Modified Davis grading
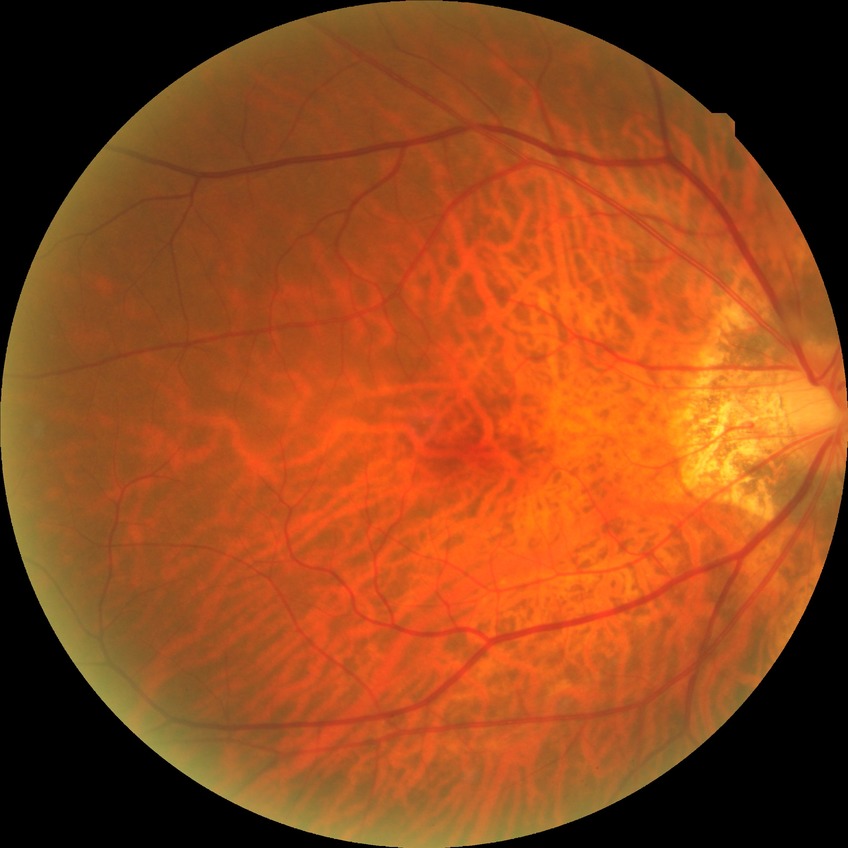 Retinopathy grade: no diabetic retinopathy.